Color fundus image: 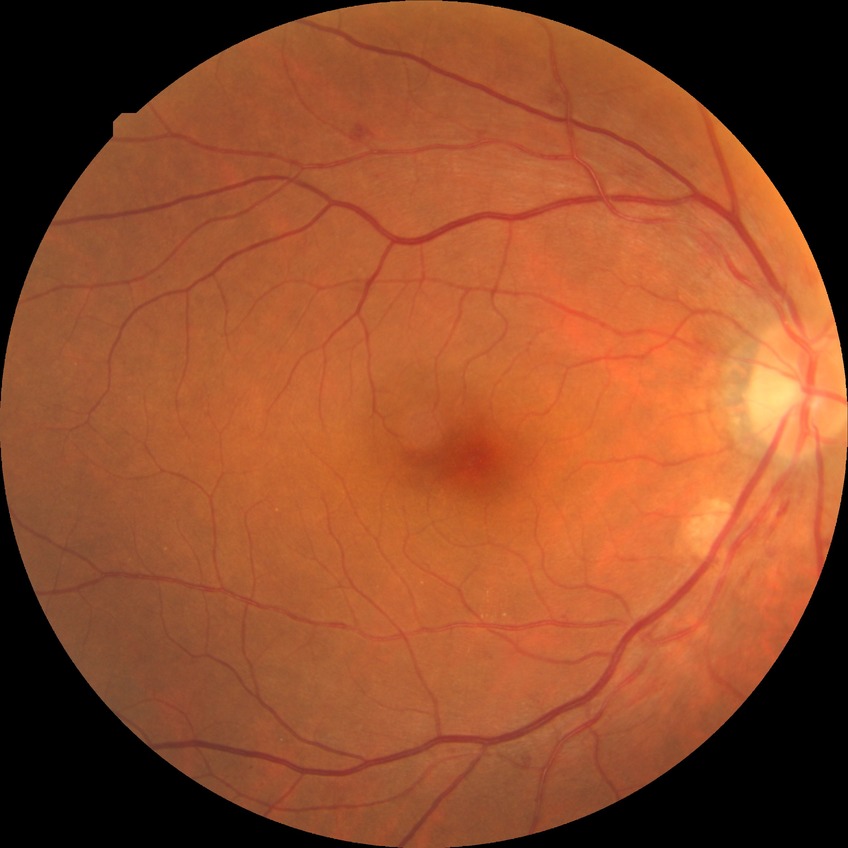

Davis stage is SDR.